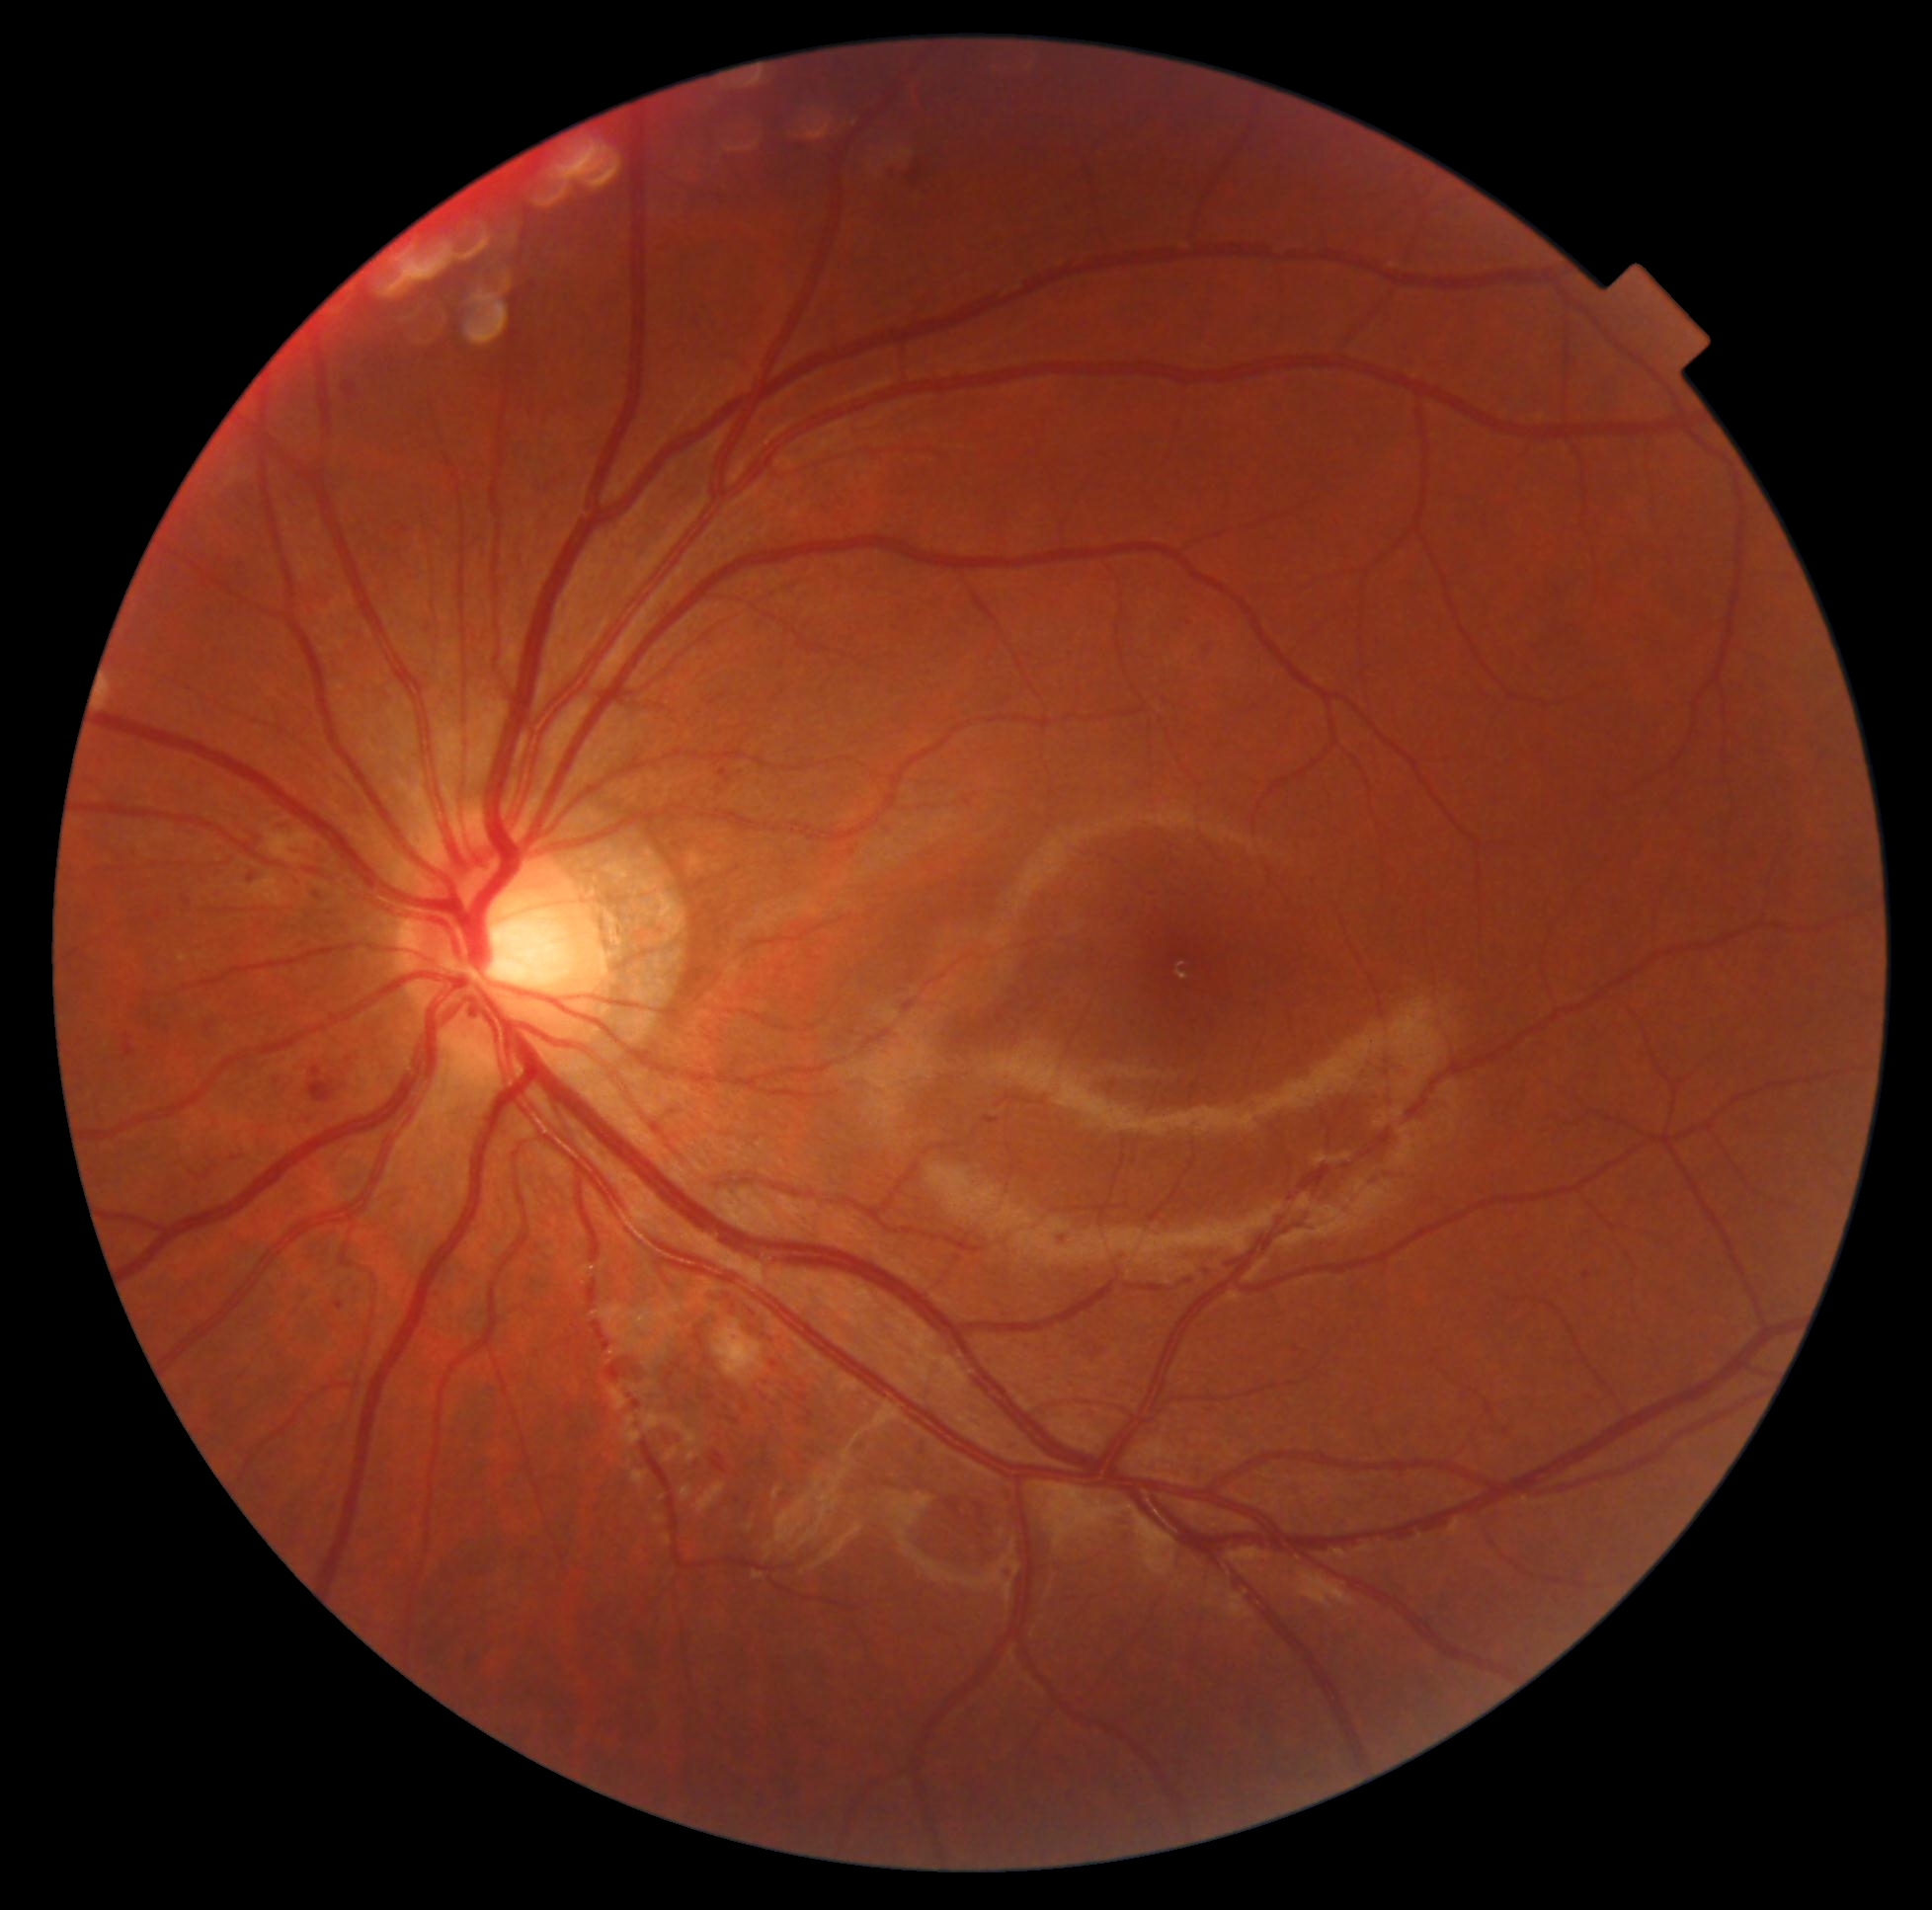 Diabetic retinopathy severity: 2.